Color fundus photograph
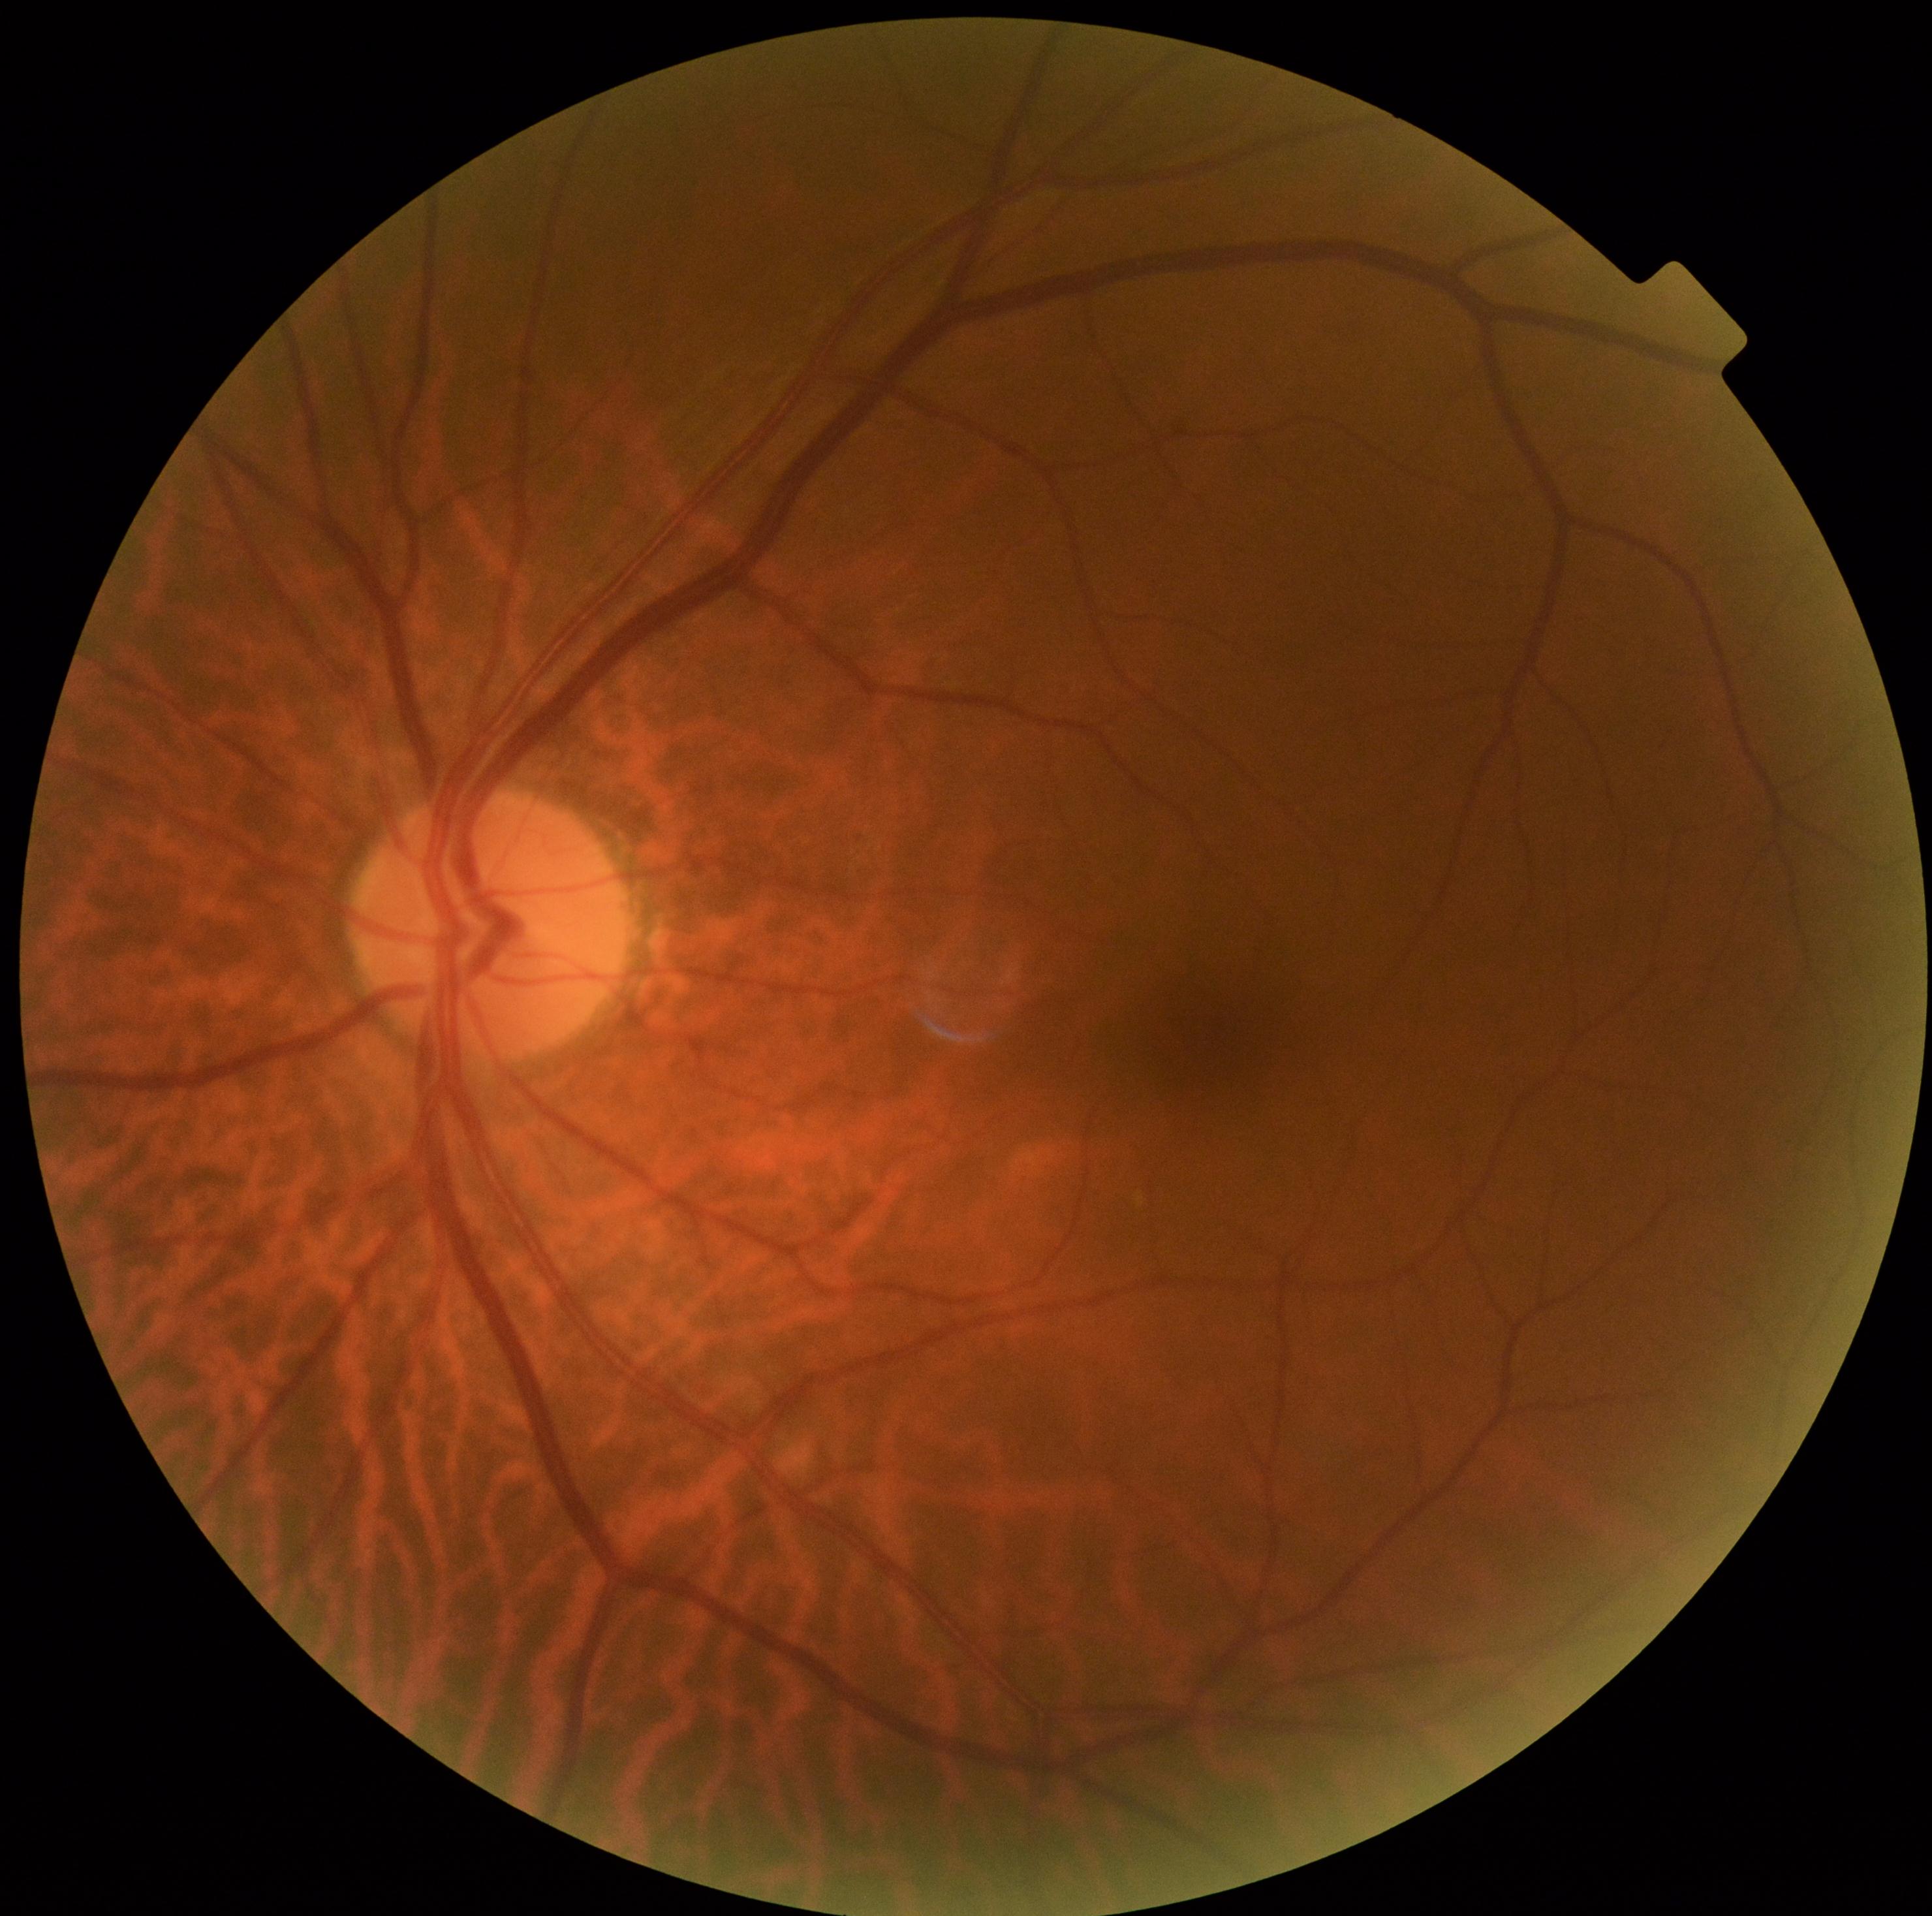
Diabetic retinopathy (DR): 0/4.